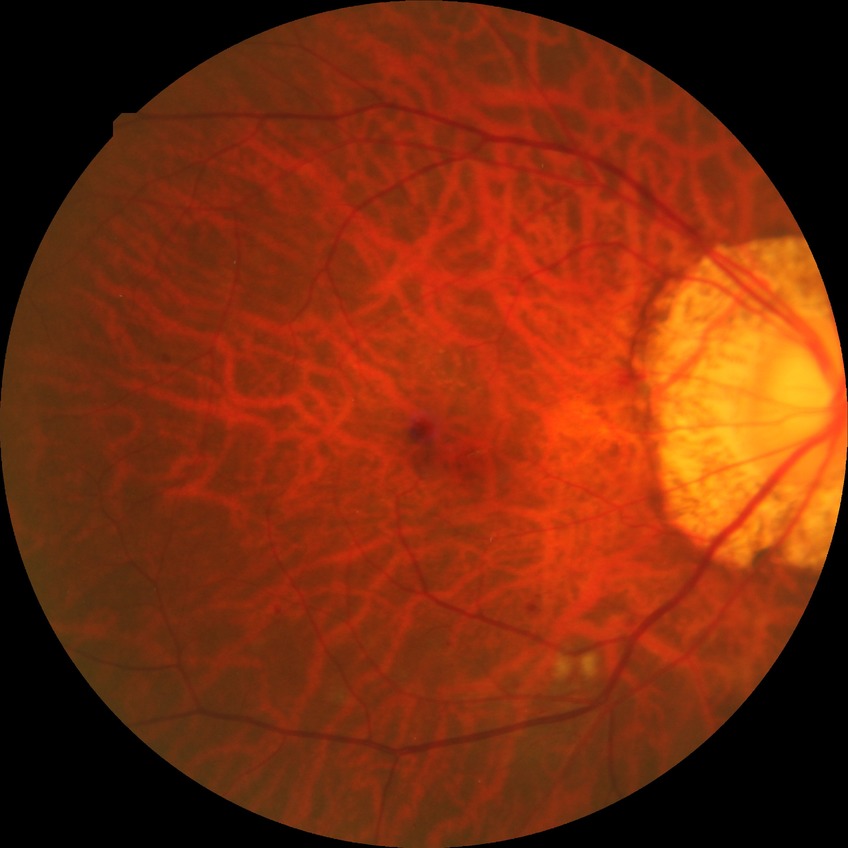
Davis grading: pre-proliferative diabetic retinopathy.